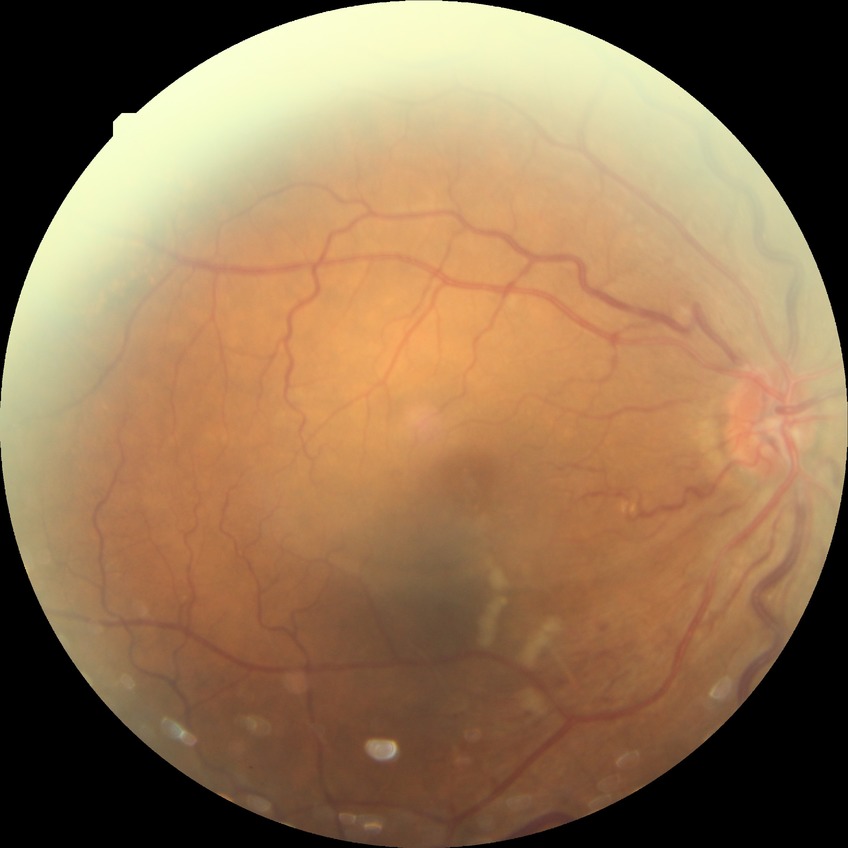
No apparent diabetic retinopathy. Modified Davis grade: NDR.